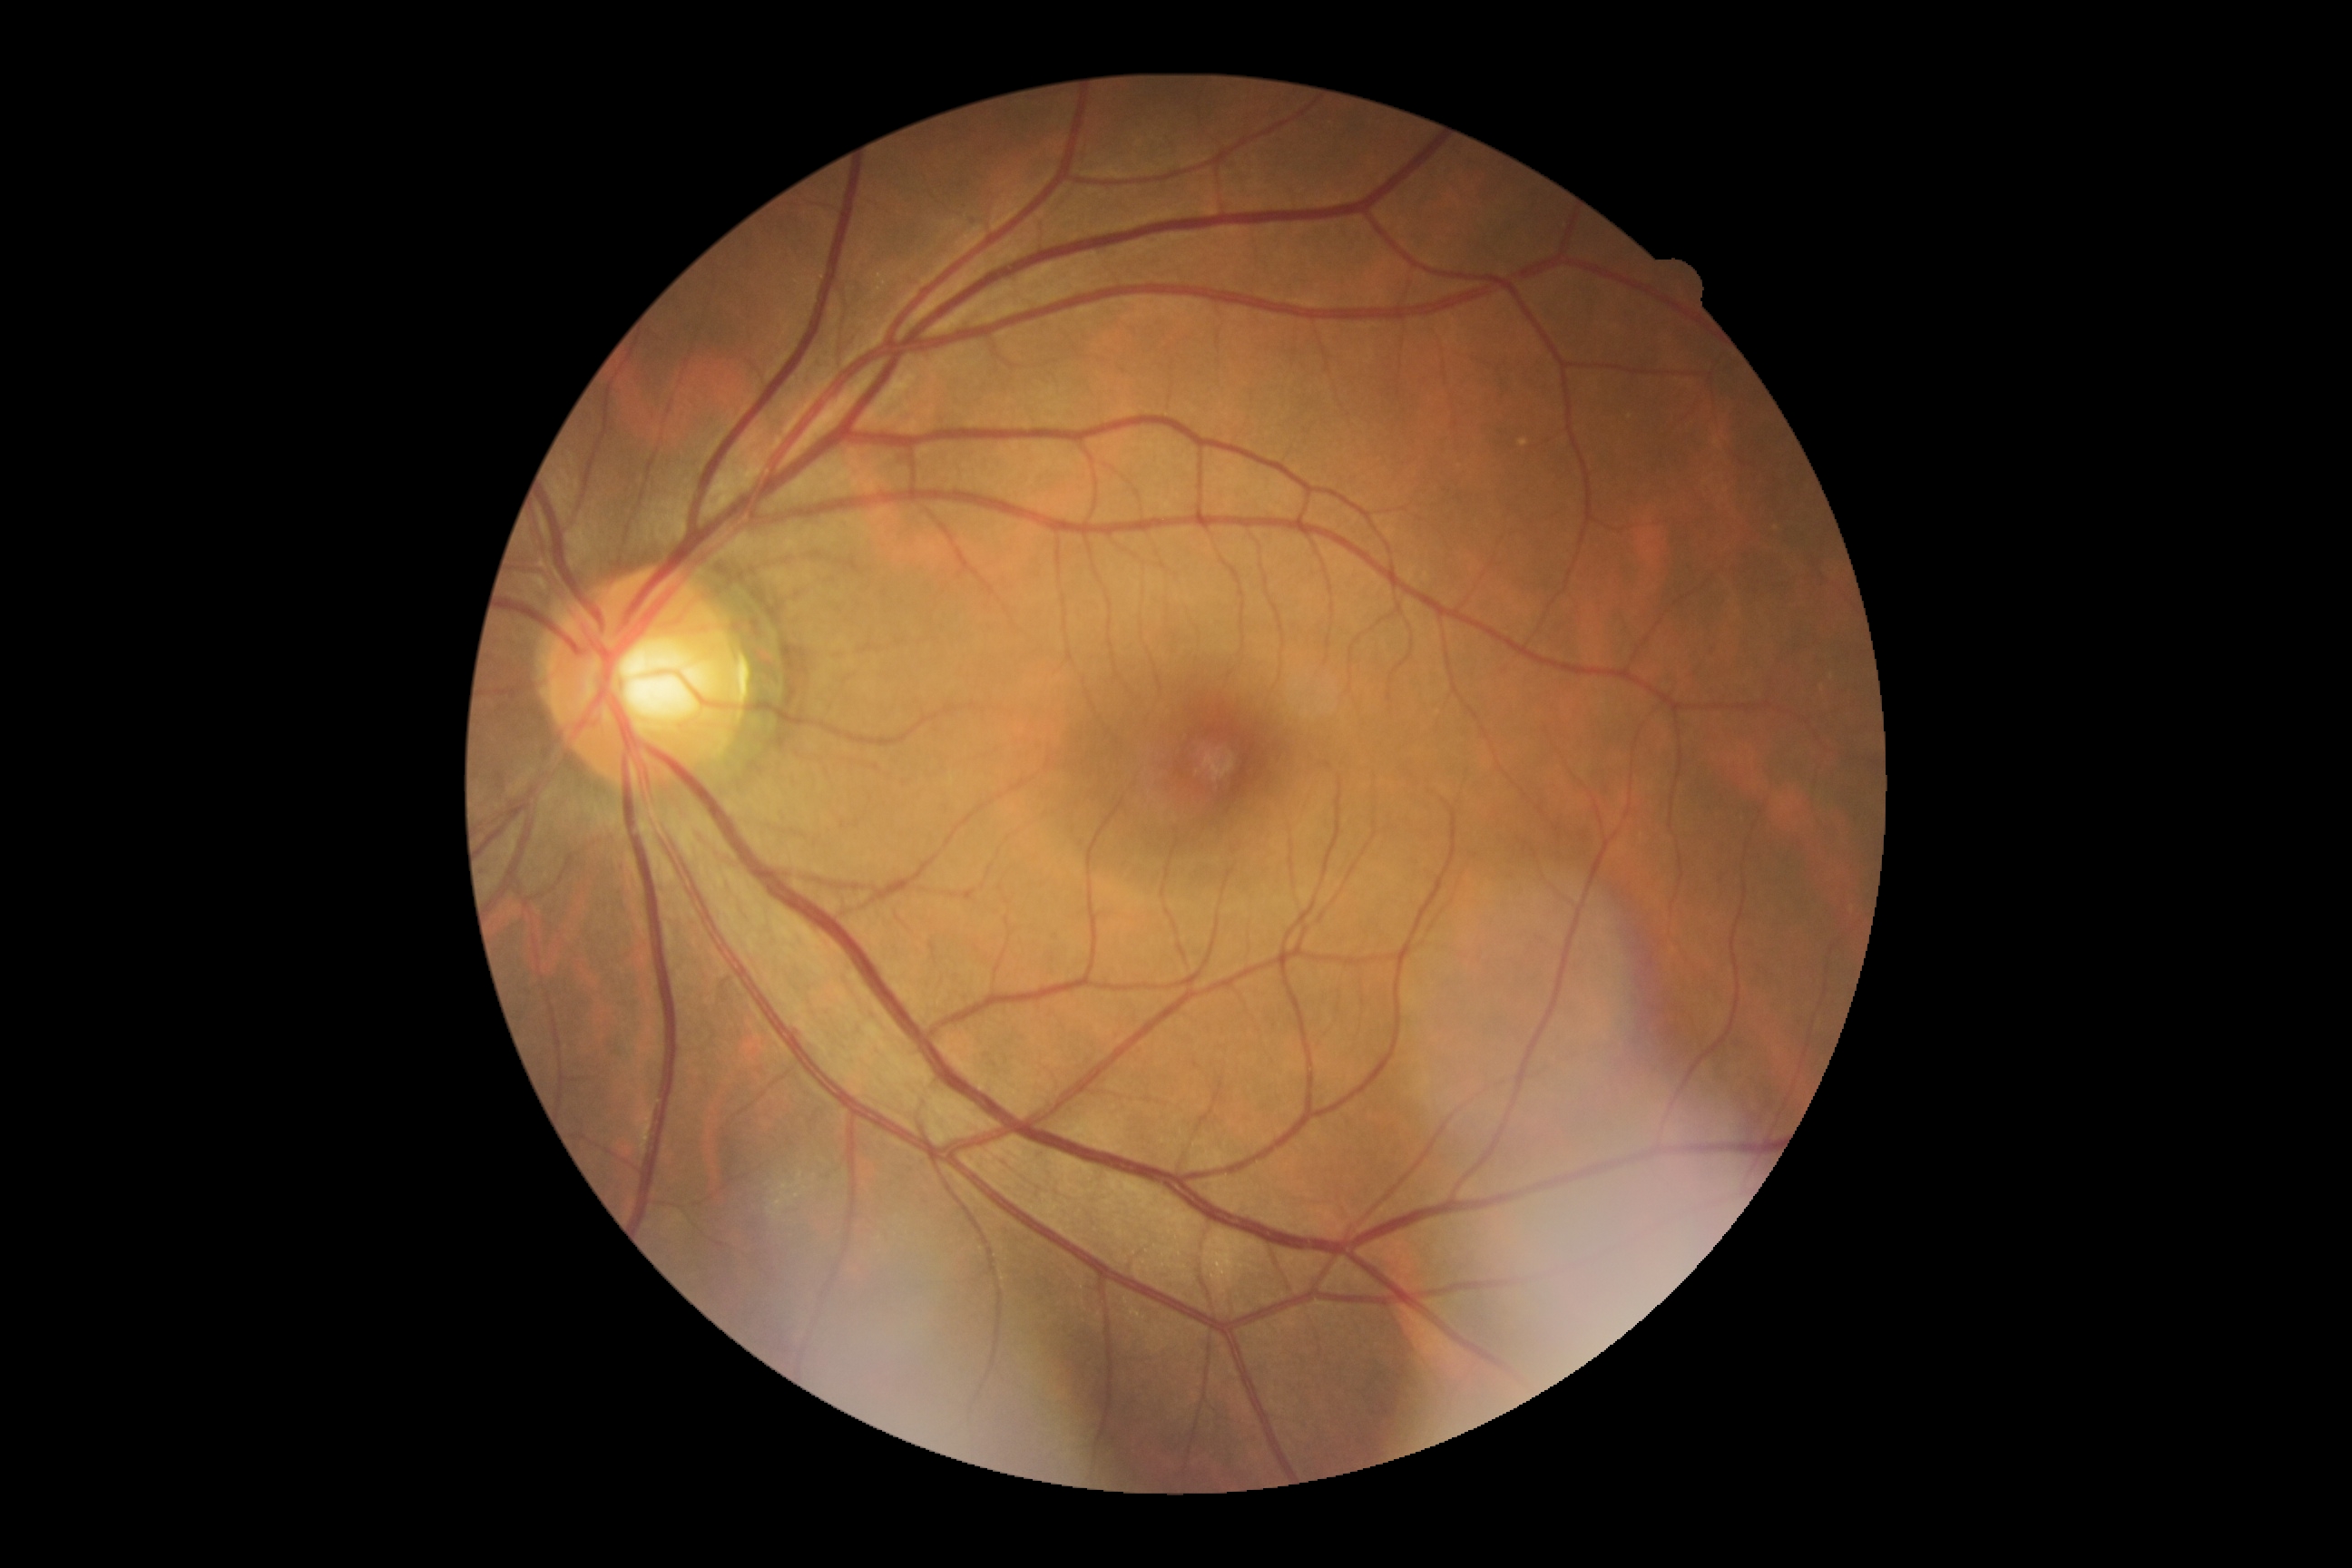

Diabetic retinopathy (DR): no apparent retinopathy (grade 0).